Phoenix ICON, 100° FOV · 1240x1240px · wide-field fundus photograph of an infant:
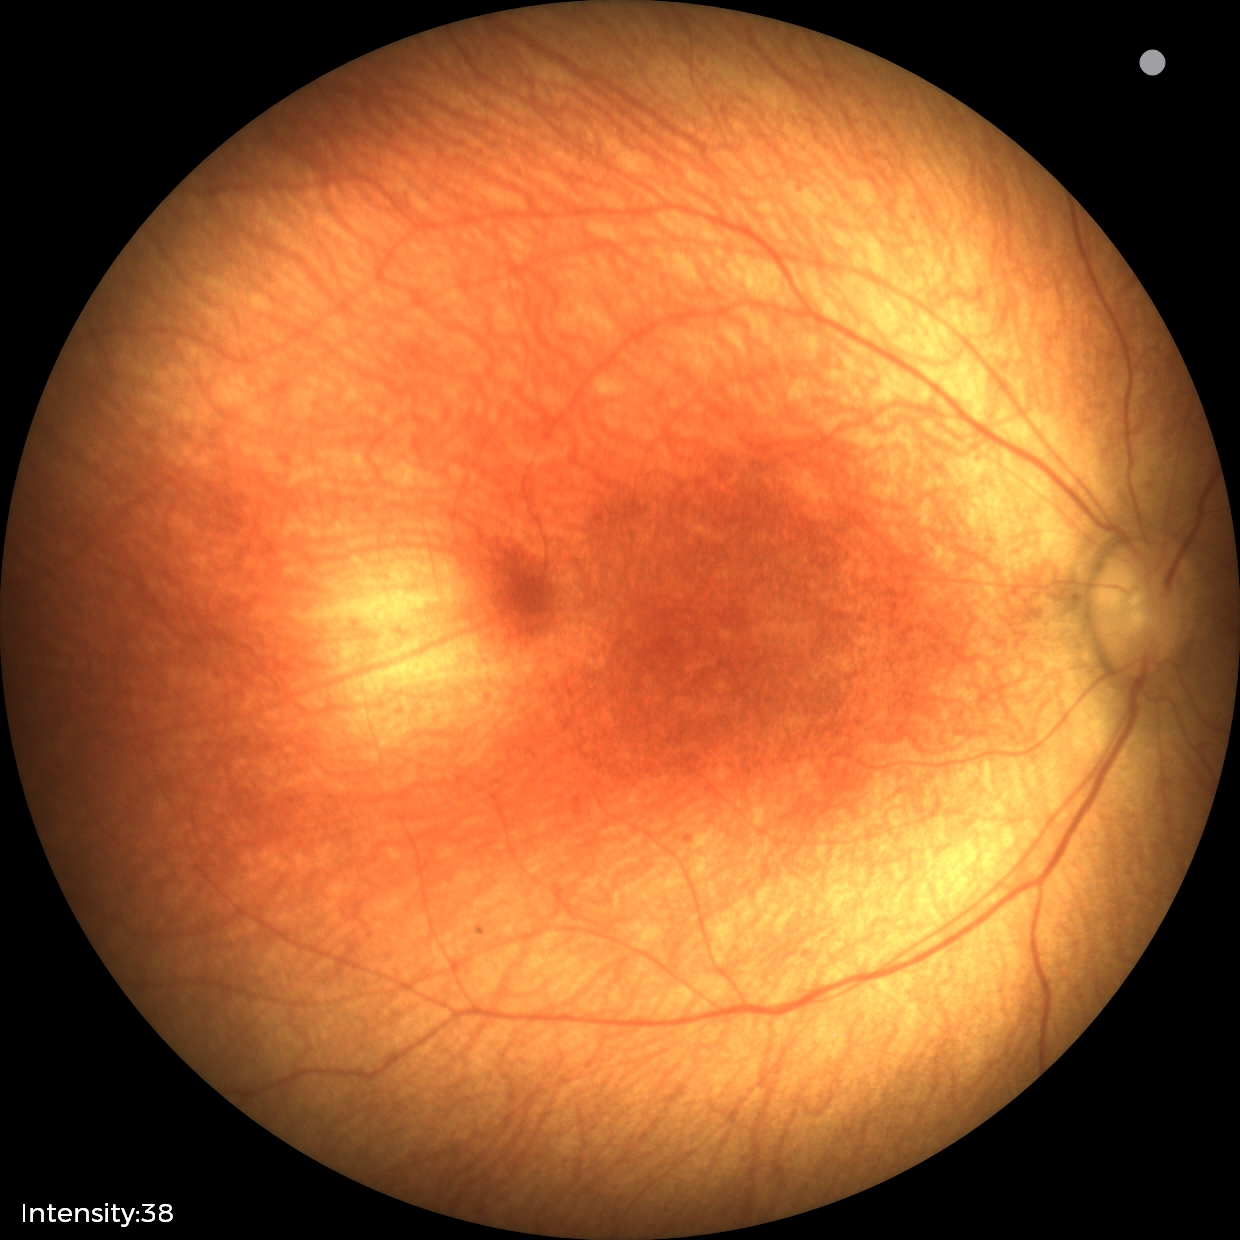
Examination with physiological retinal findings.